Wide-field fundus photograph of an infant: 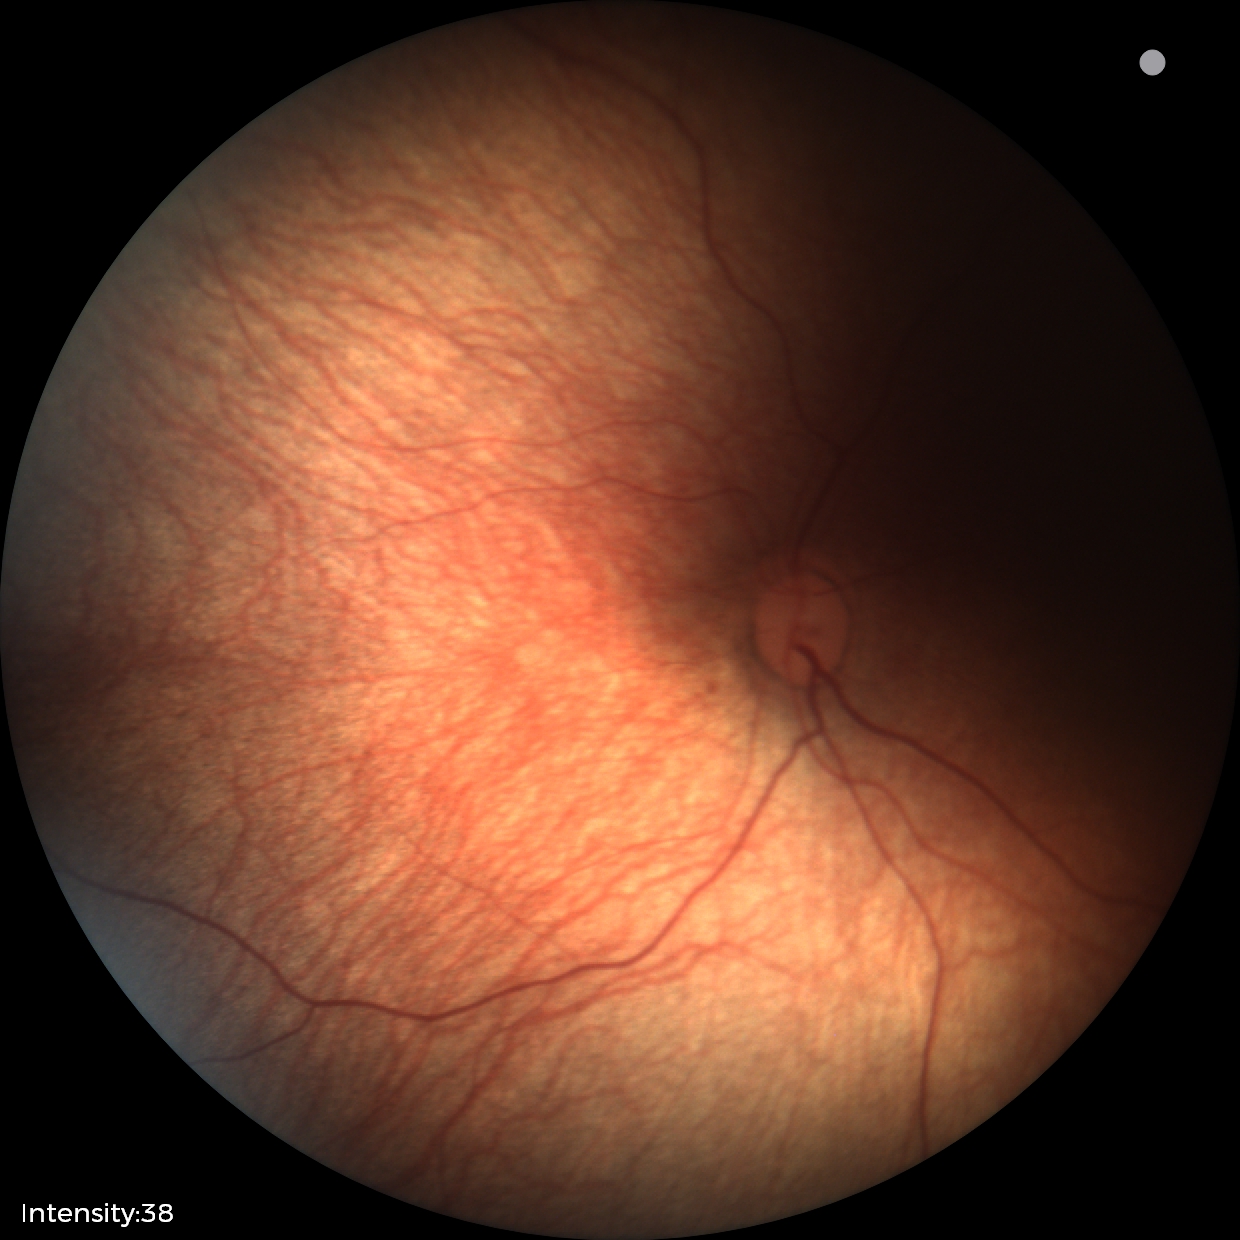 Screening diagnosis: no abnormalities.